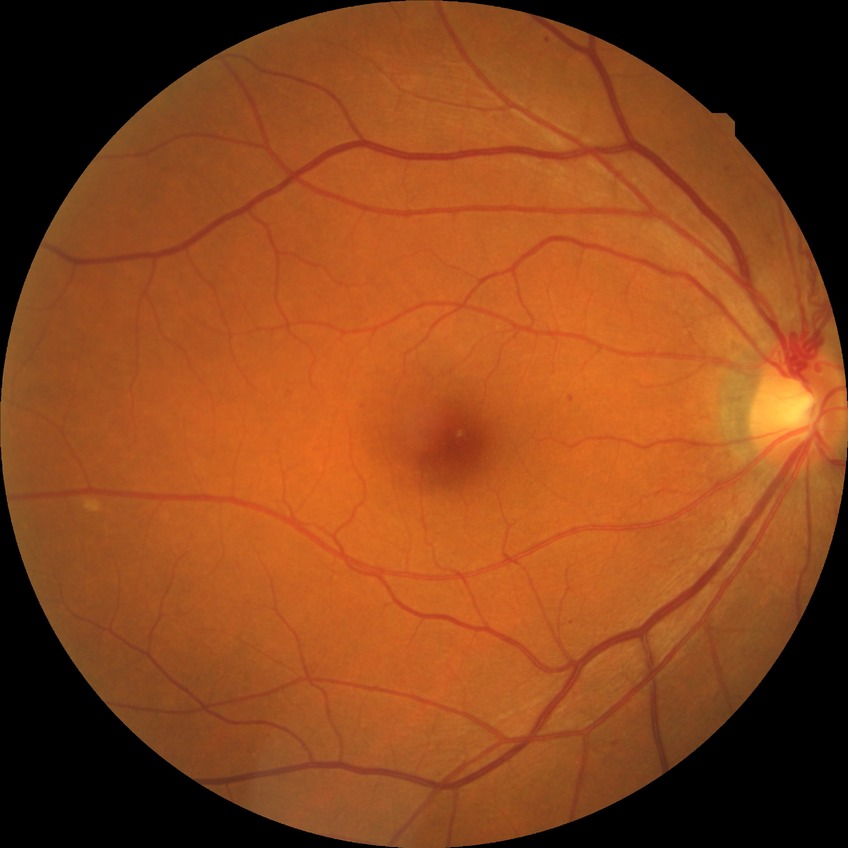
davis_grade: SDR (simple diabetic retinopathy)